1932x1932px. Retinal fundus photograph. FOV: 50 degrees.
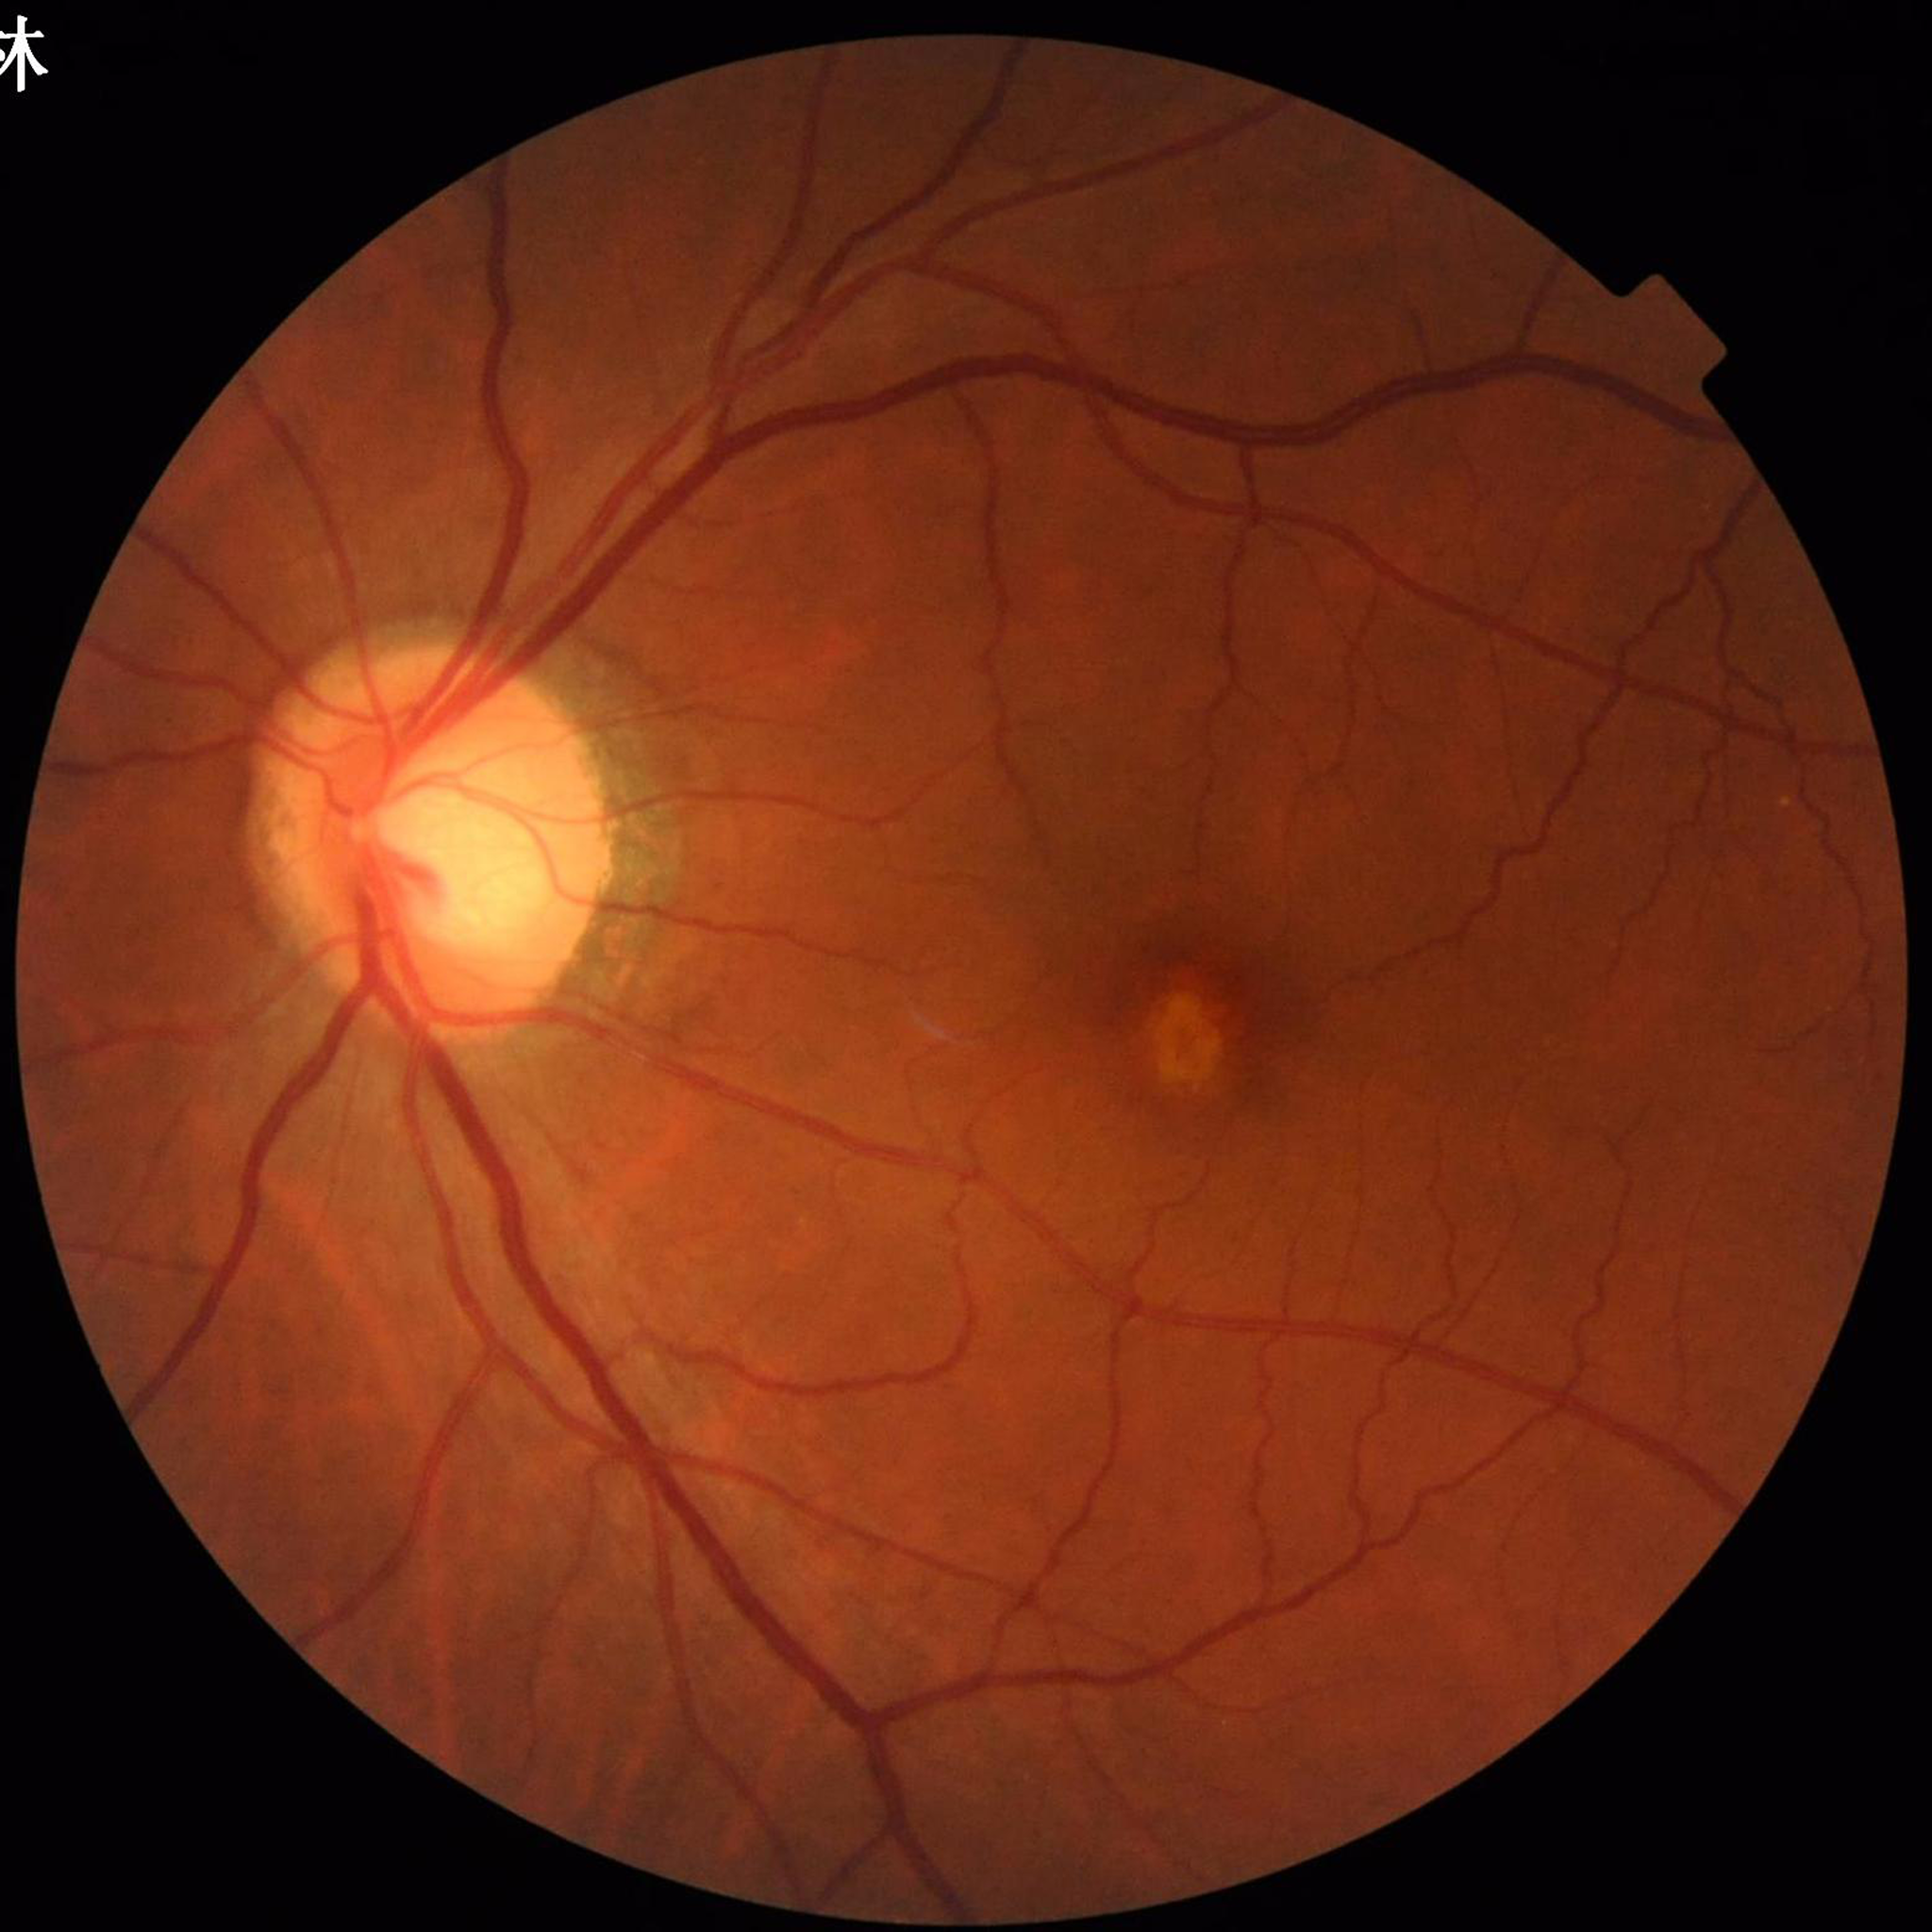
  diagnosis: AMD
  image_quality: adequate